Color fundus photograph:
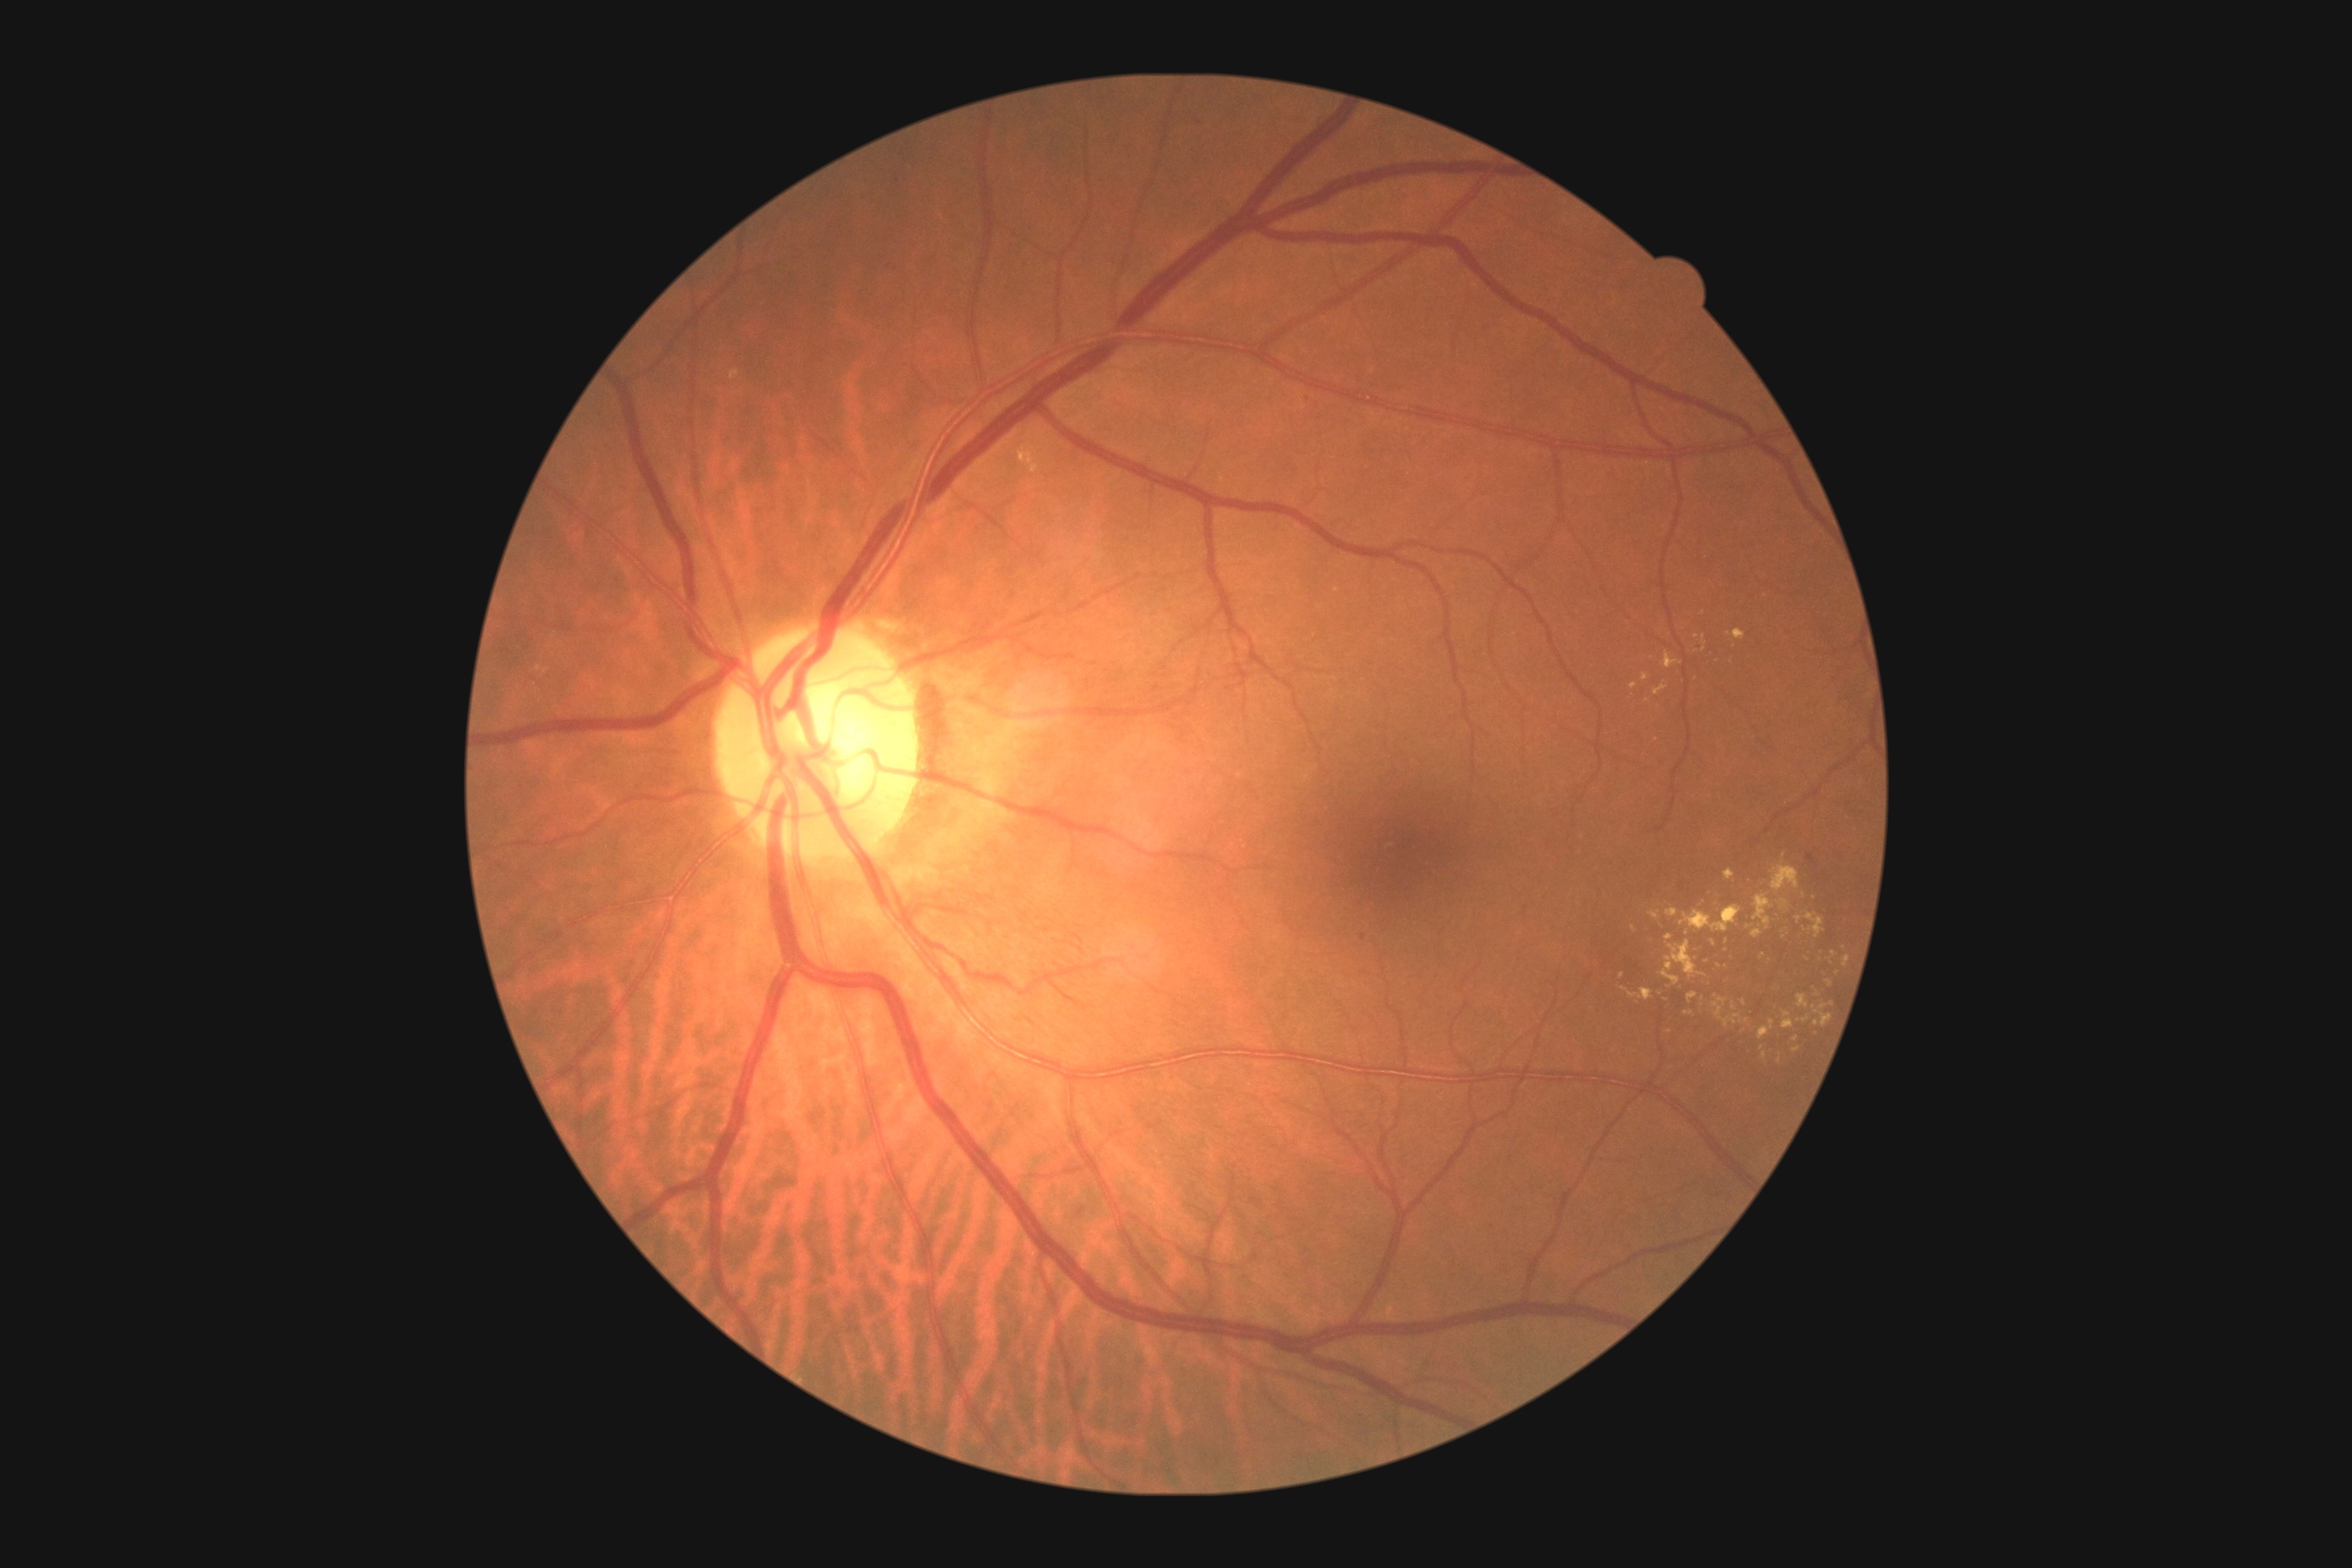
DR grade@2/4; DR class@non-proliferative diabetic retinopathy.